Clarity RetCam 3, 130° FOV. Pediatric wide-field fundus photograph. 640x480
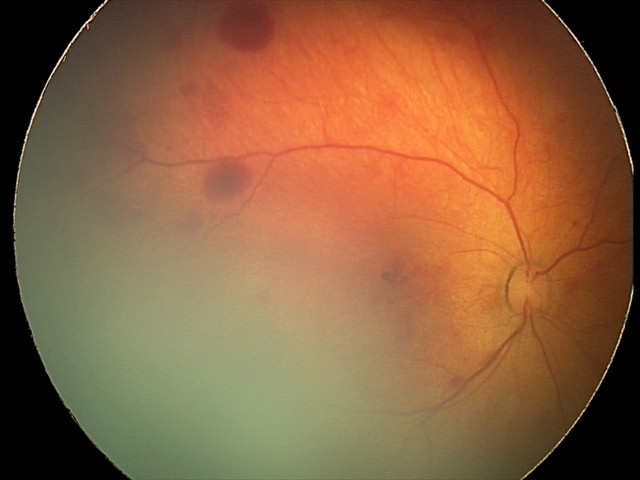 From an examination with diagnosis of retinal hemorrhages.